Wide-field fundus photograph from neonatal ROP screening:
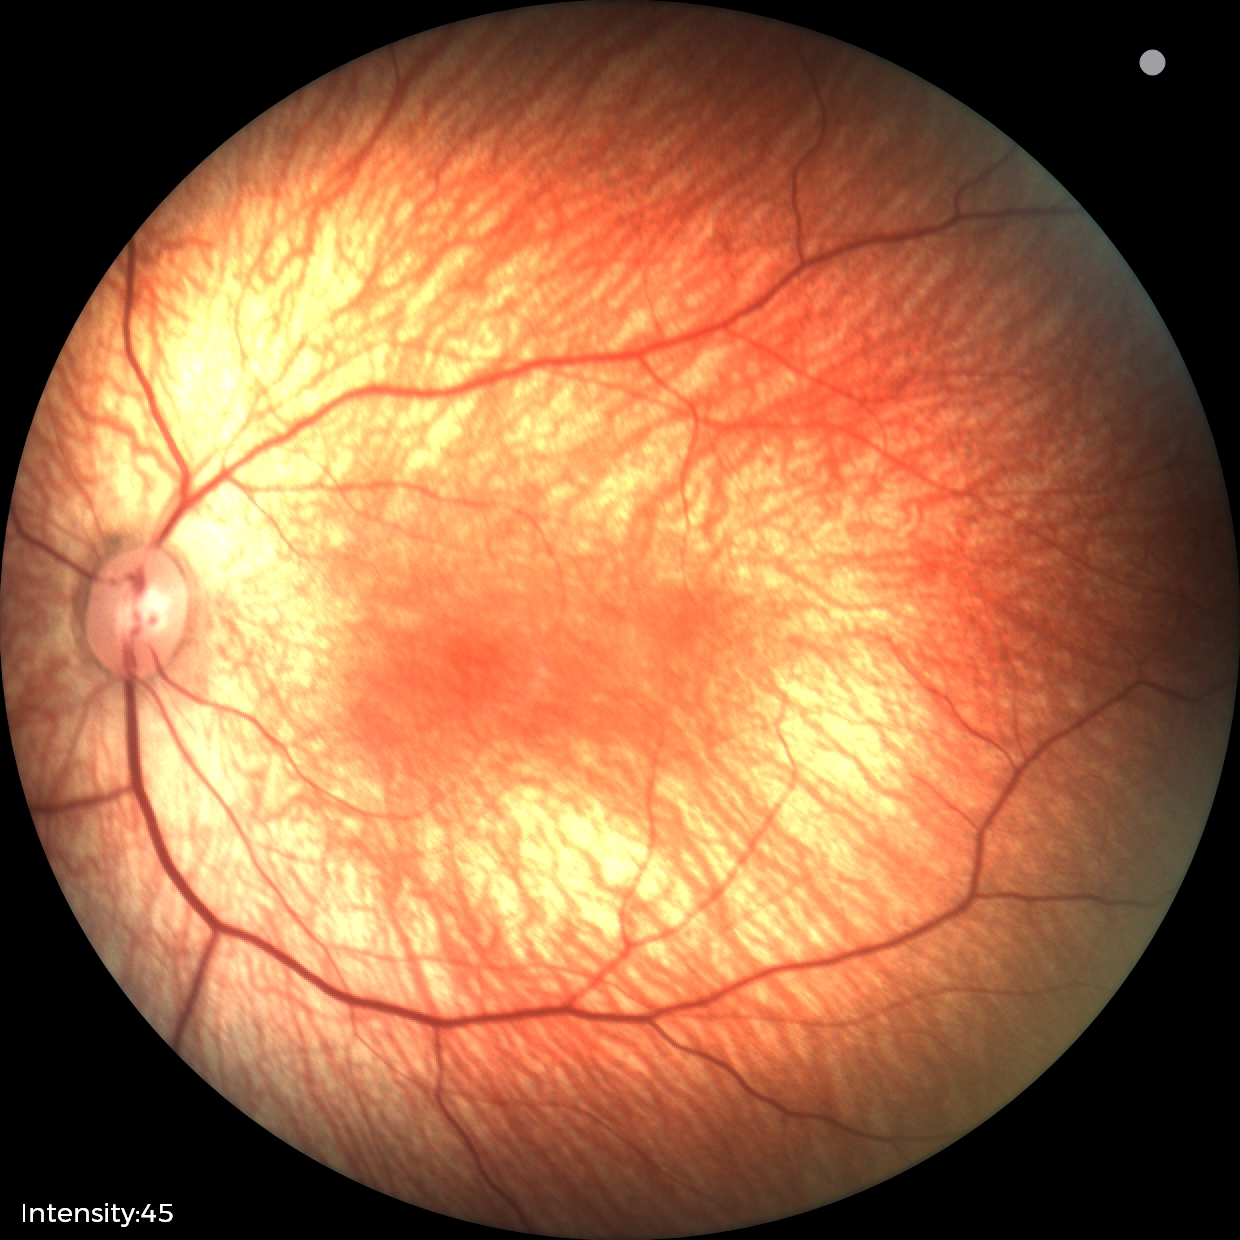 Physiological retinal appearance for postconceptual age.